Nonmydriatic fundus photograph: 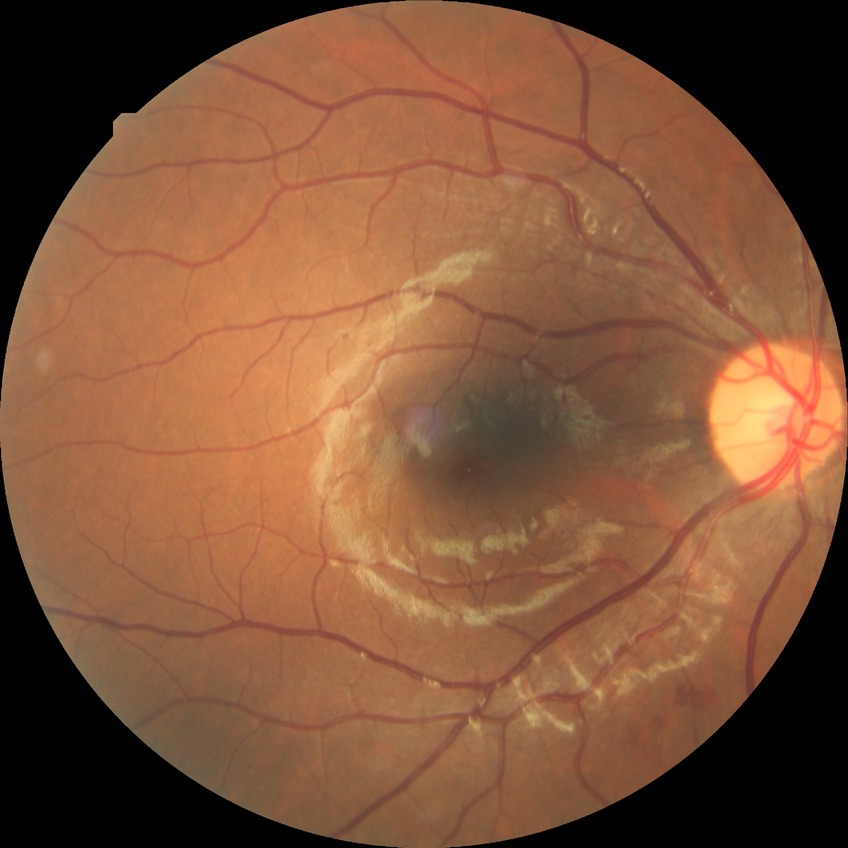 Diabetic retinopathy (DR) is simple diabetic retinopathy (SDR).